1240x1240. Wide-field contact fundus photograph of an infant
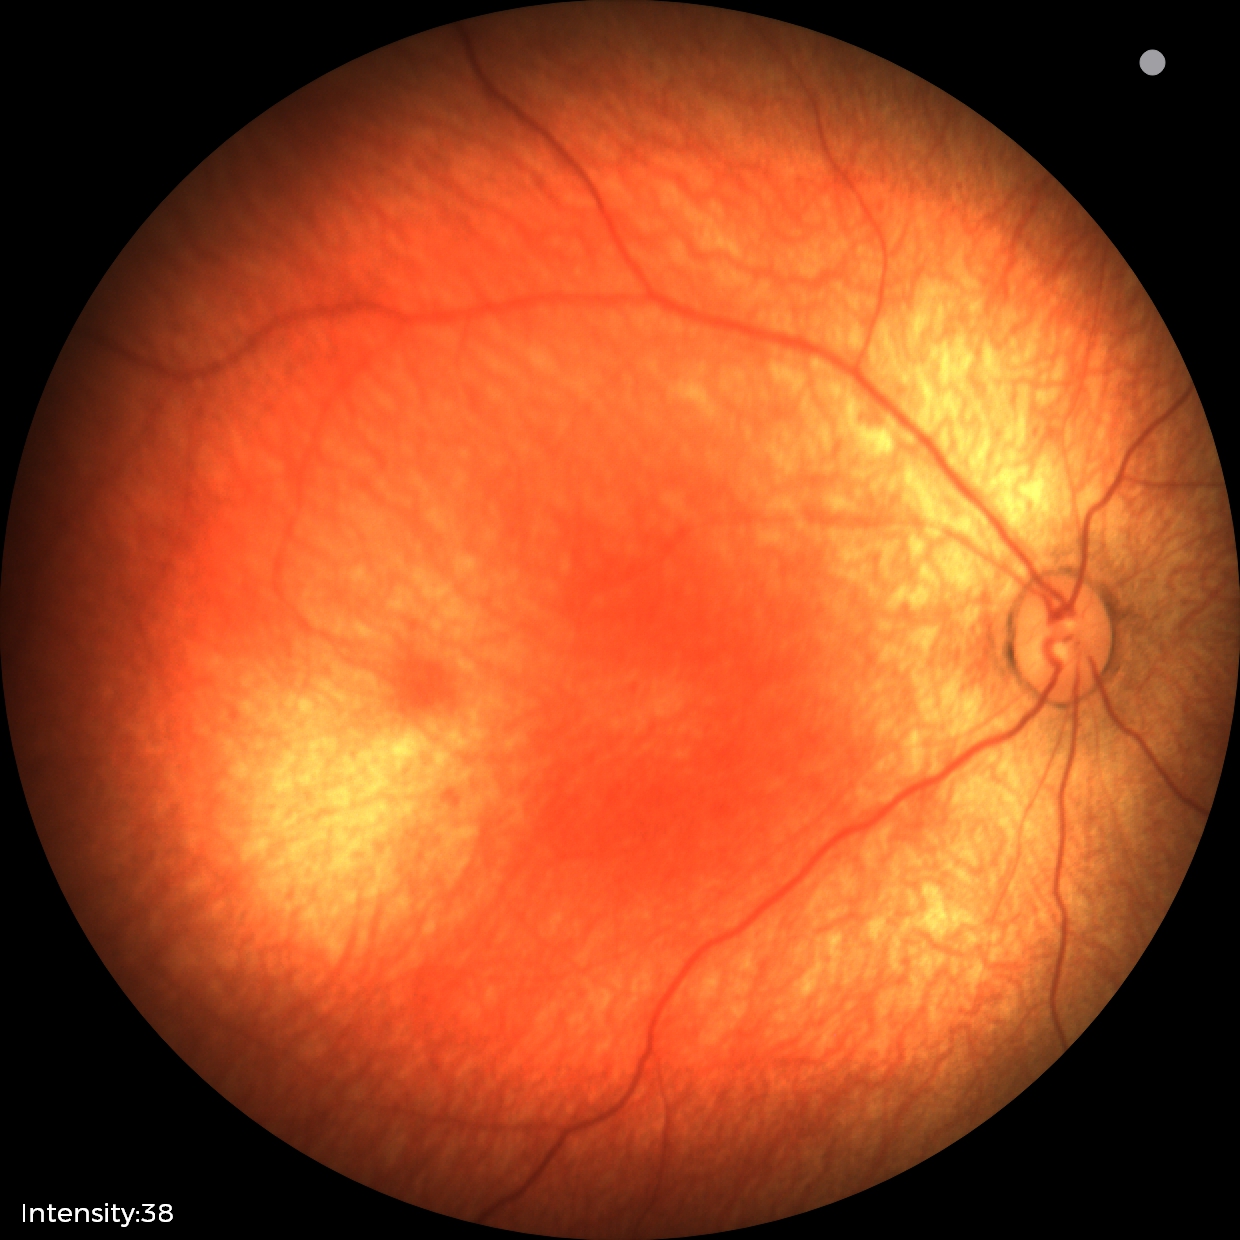
Physiological retinal appearance for postconceptual age.